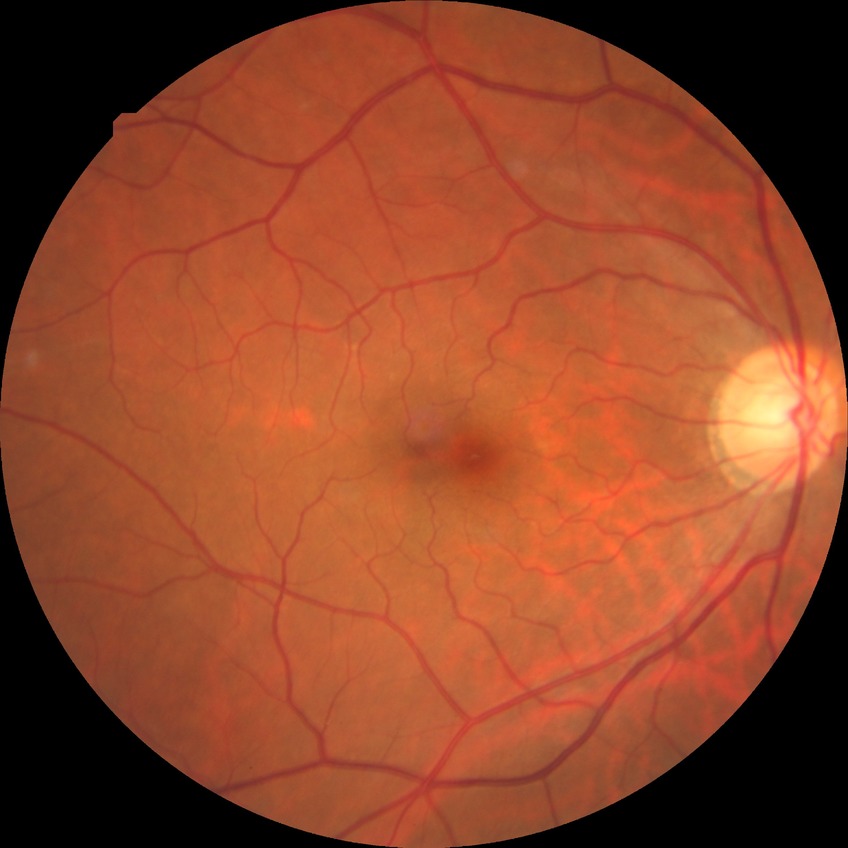

  davis_grade: no diabetic retinopathy (NDR)